Wide-field fundus photograph from neonatal ROP screening — 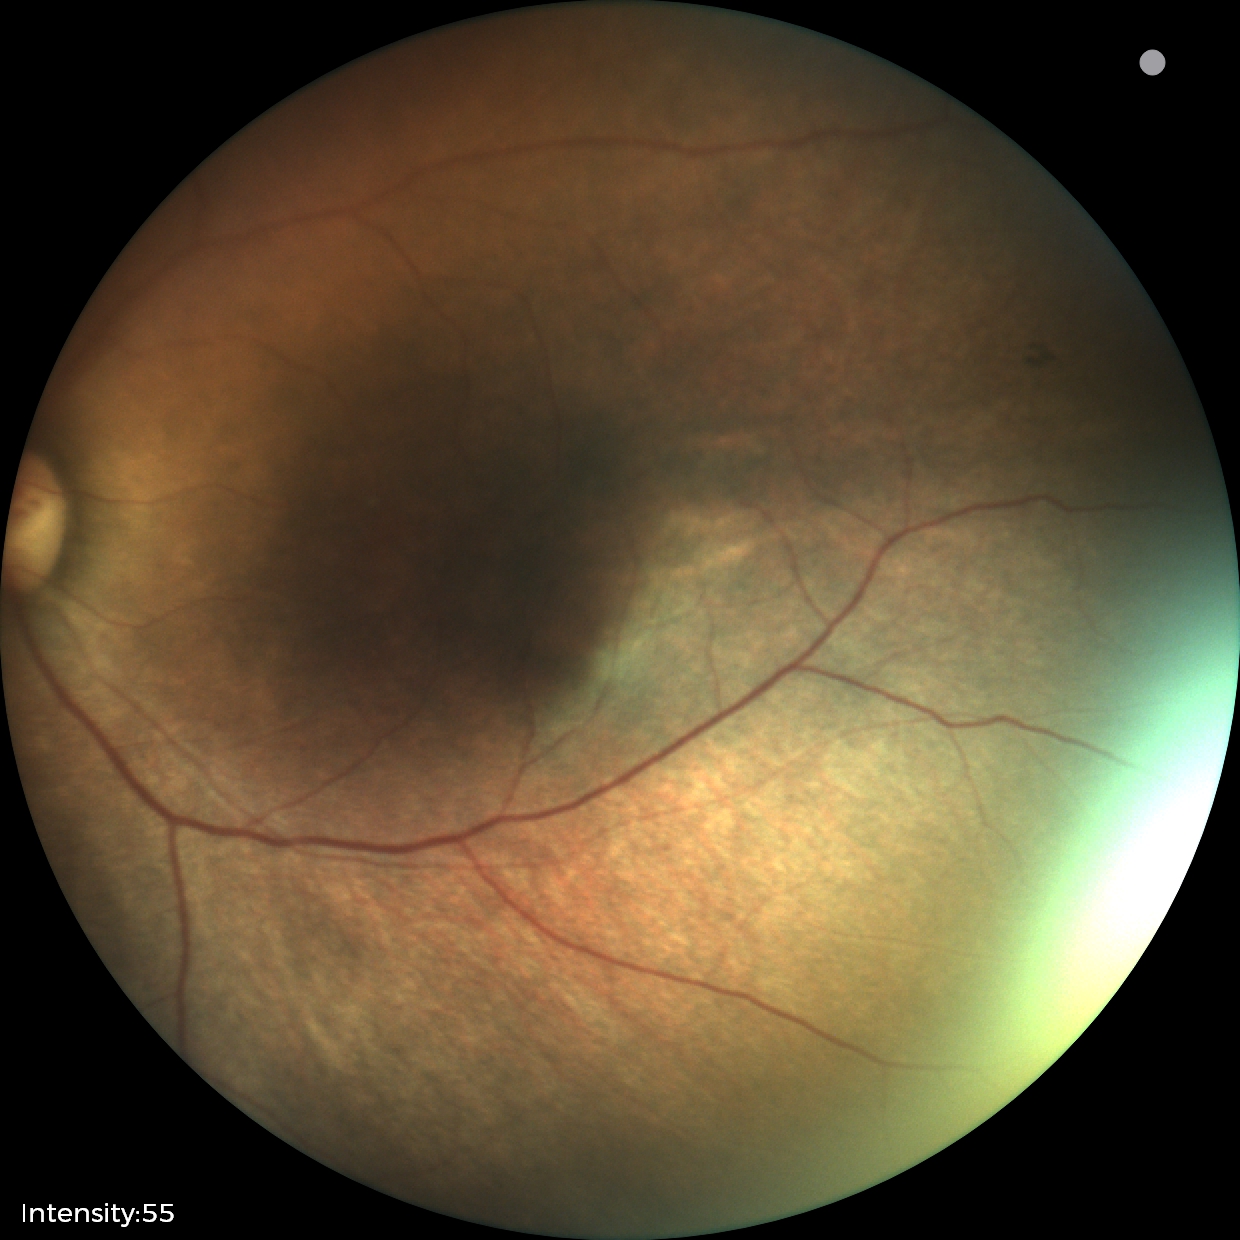
Screening: status post retinopathy of prematurity (ROP).